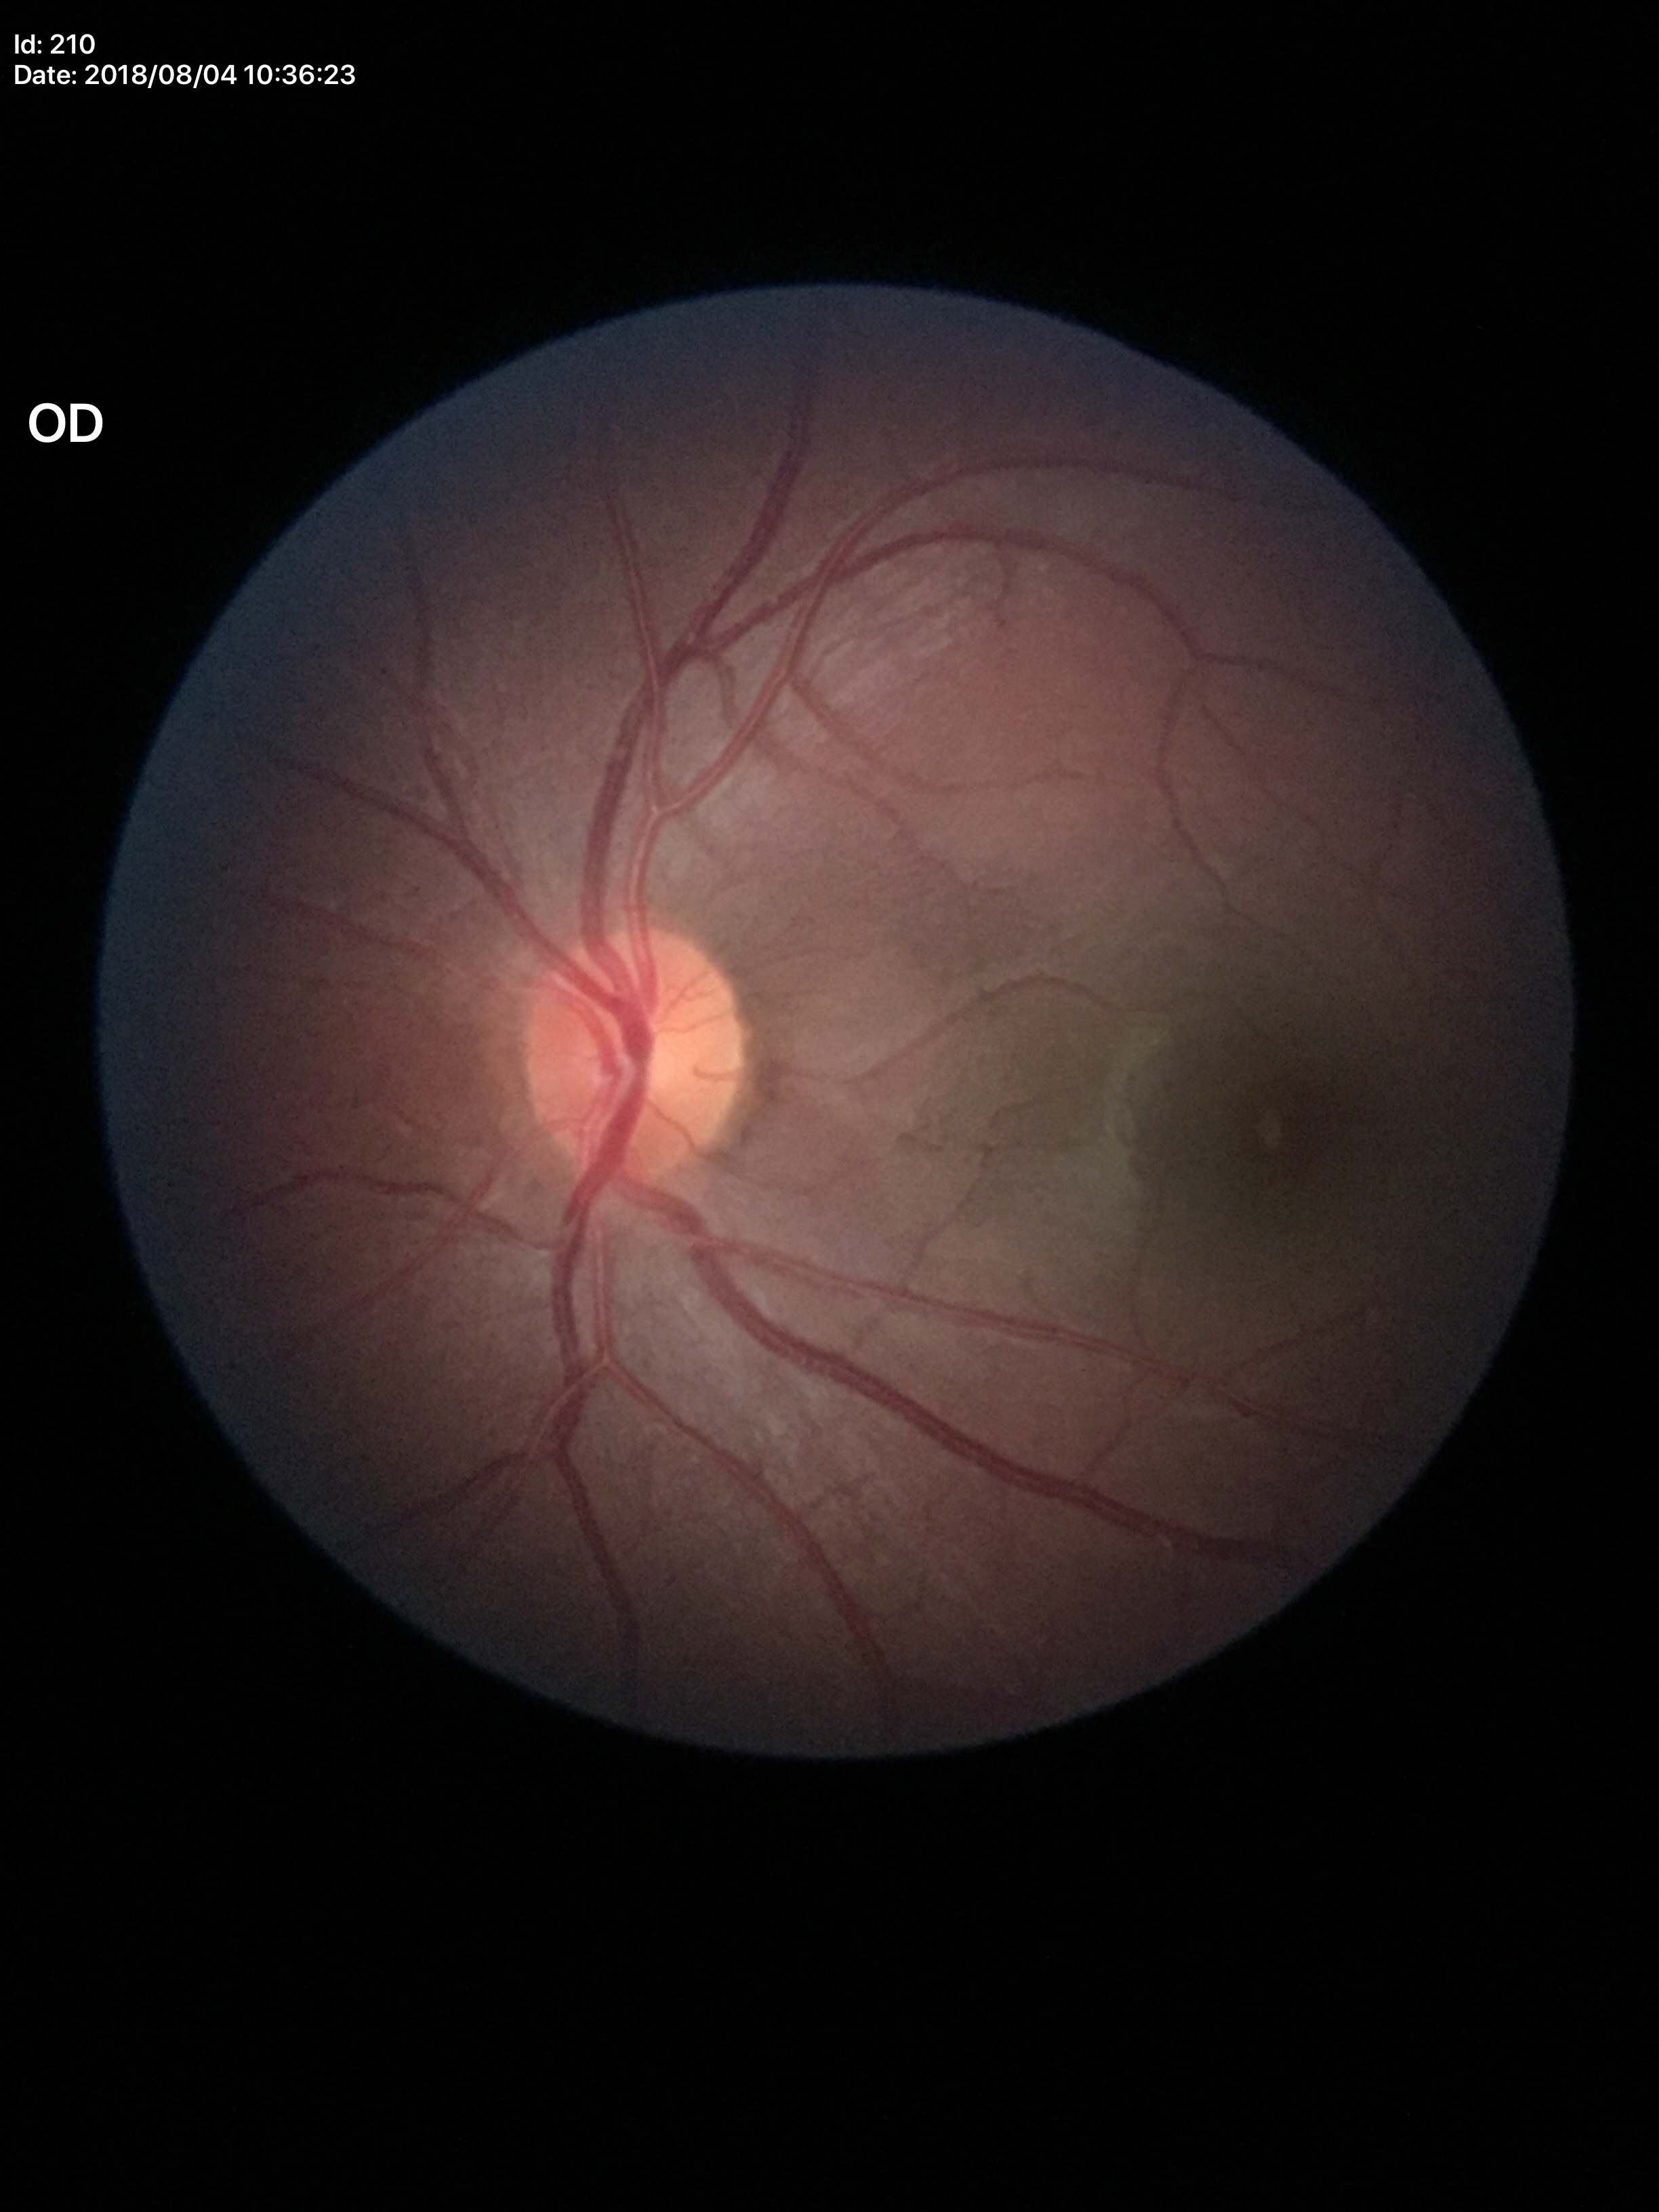

Glaucoma impression = negative; vertical C/D ratio (VCDR) = 0.45.